Camera: NIDEK AFC-230 · 848 x 848 pixels · 45° field of view — 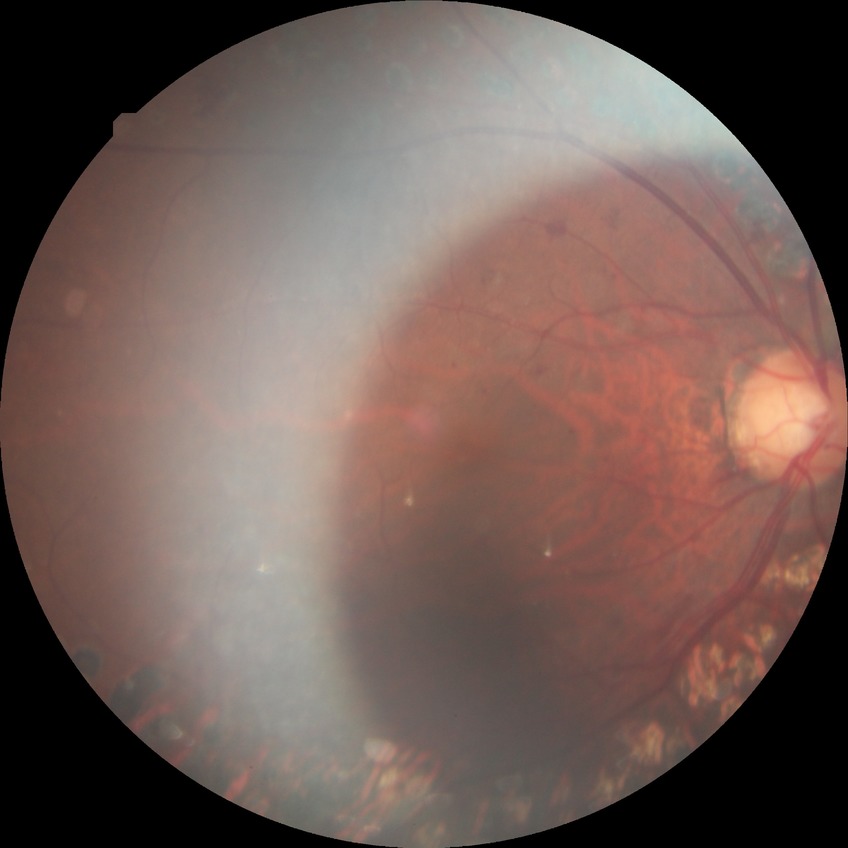
  davis_grade: PDR